848 x 848 pixels:
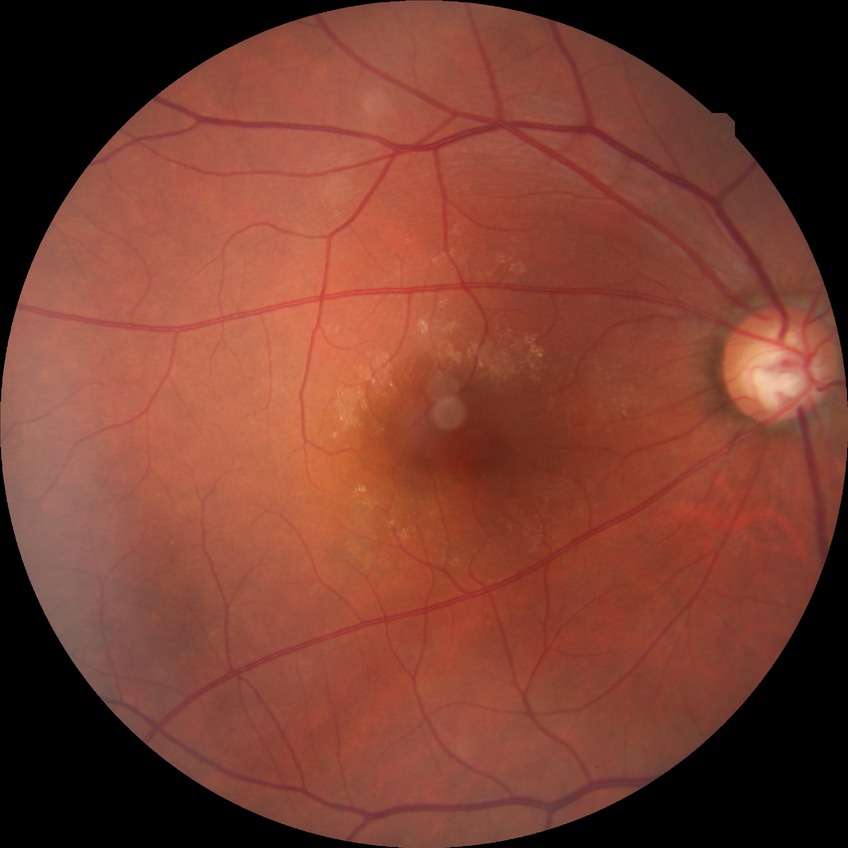

davis_grade: NDR